Ultra-widefield (UWF) fundus image
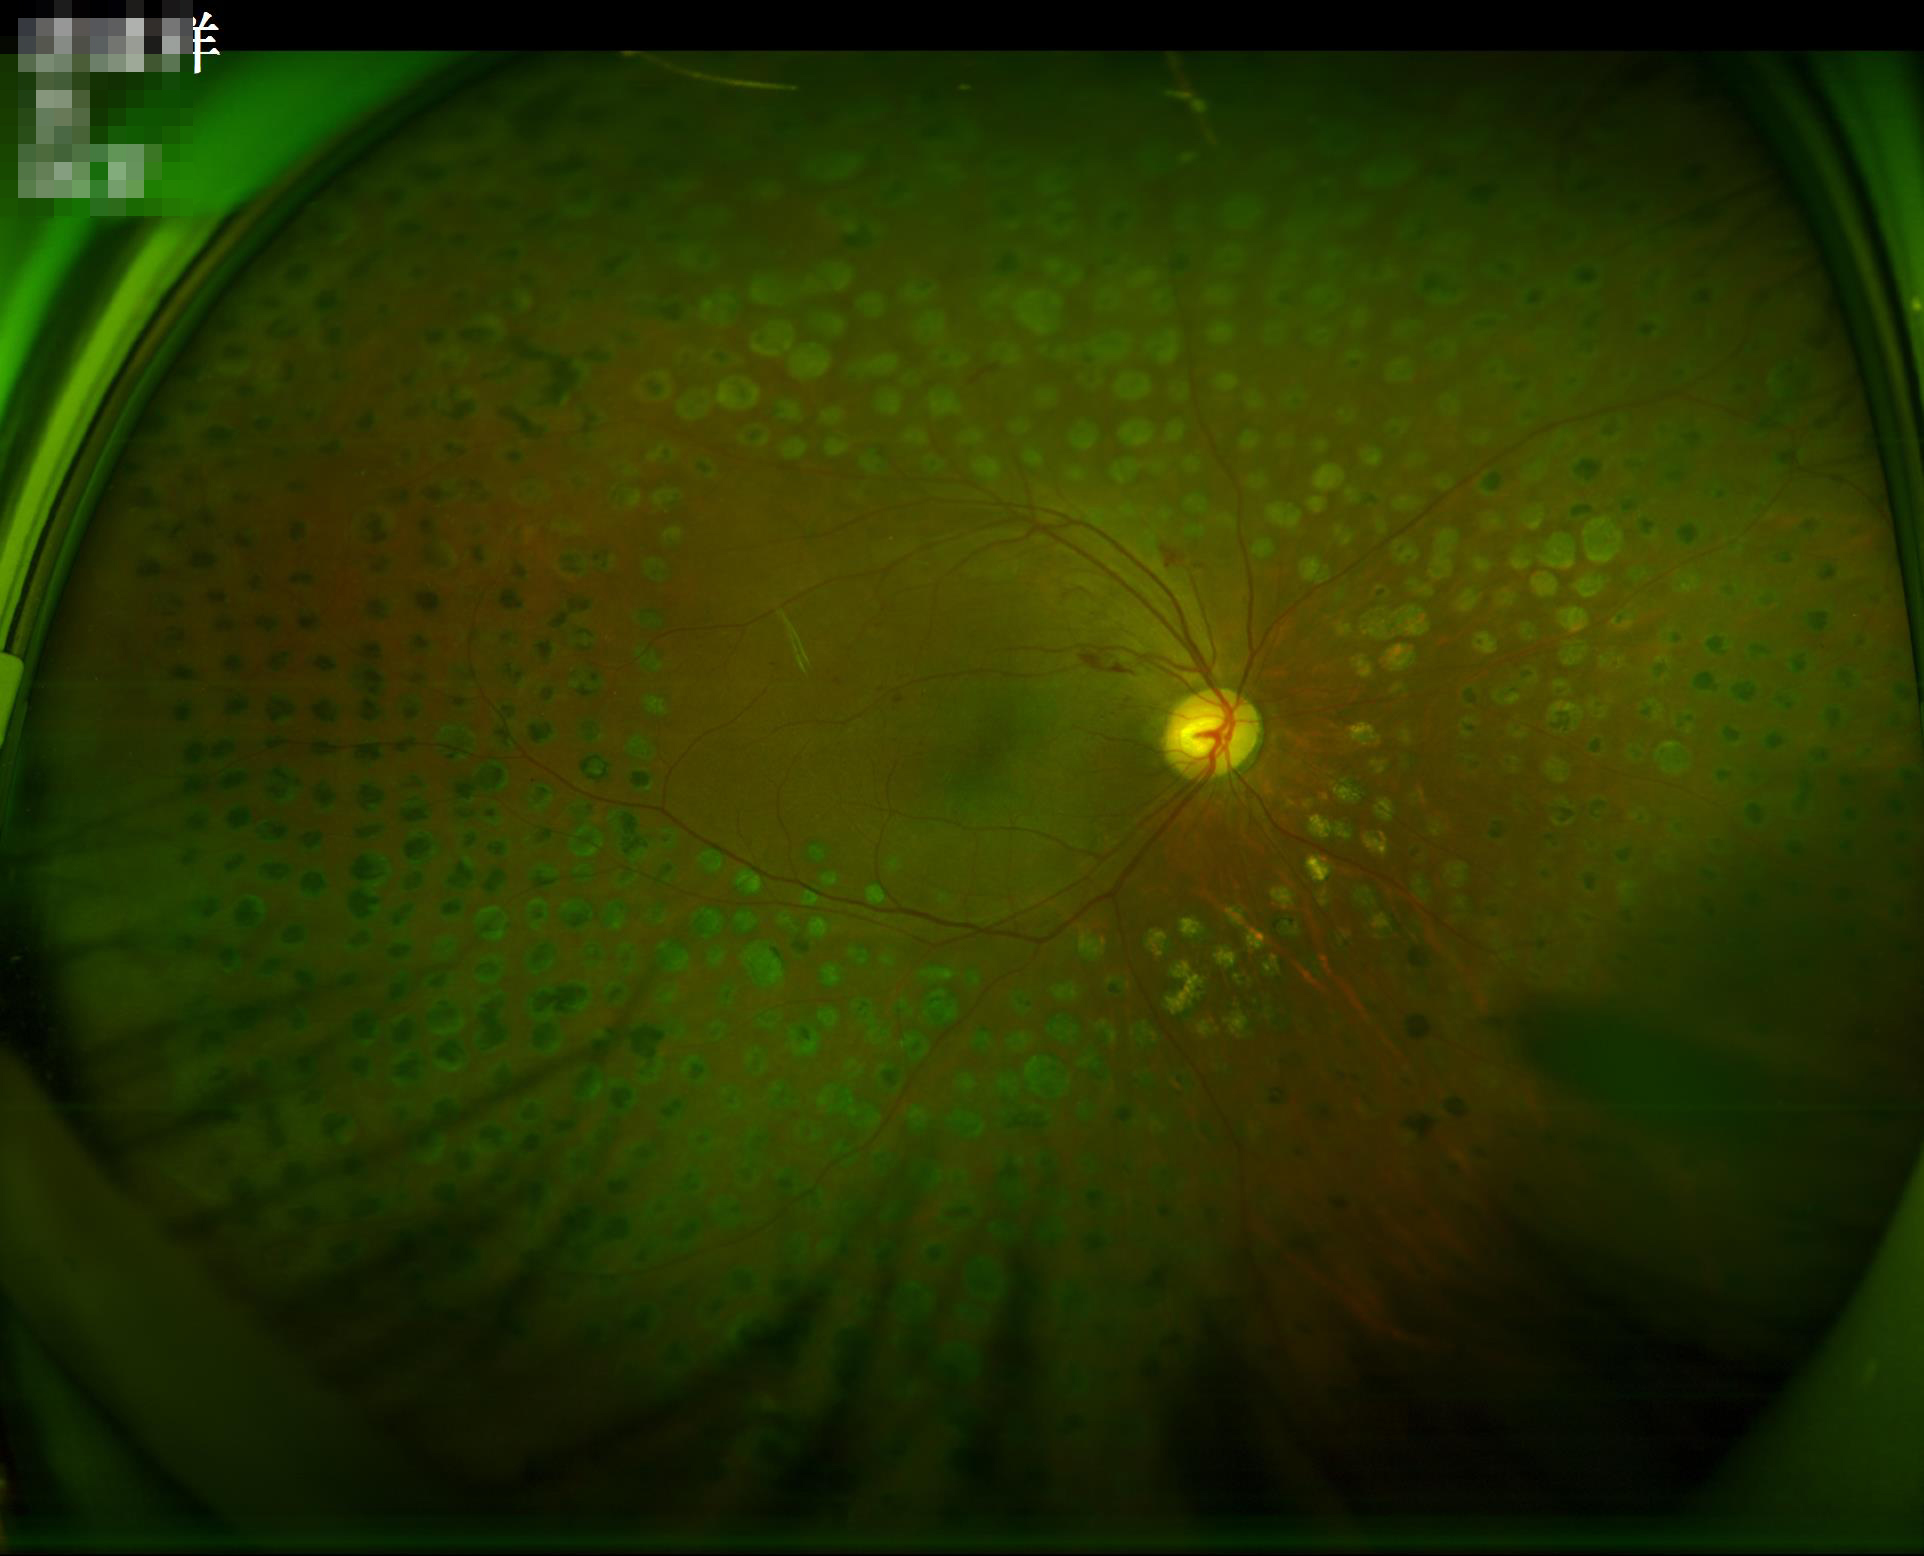

Overall: adequate; Contrast: satisfactory; Illumination/color: suboptimal.